Optic disc photograph · image size 388x388: 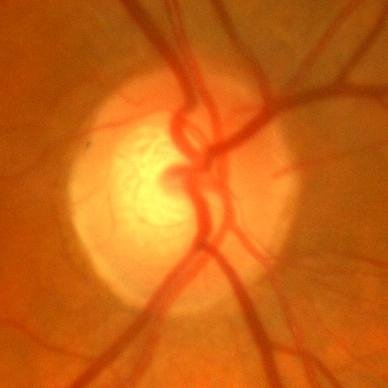
The image shows no signs of glaucoma.